Remidio Fundus on Phone · 1659 by 2212 pixels: 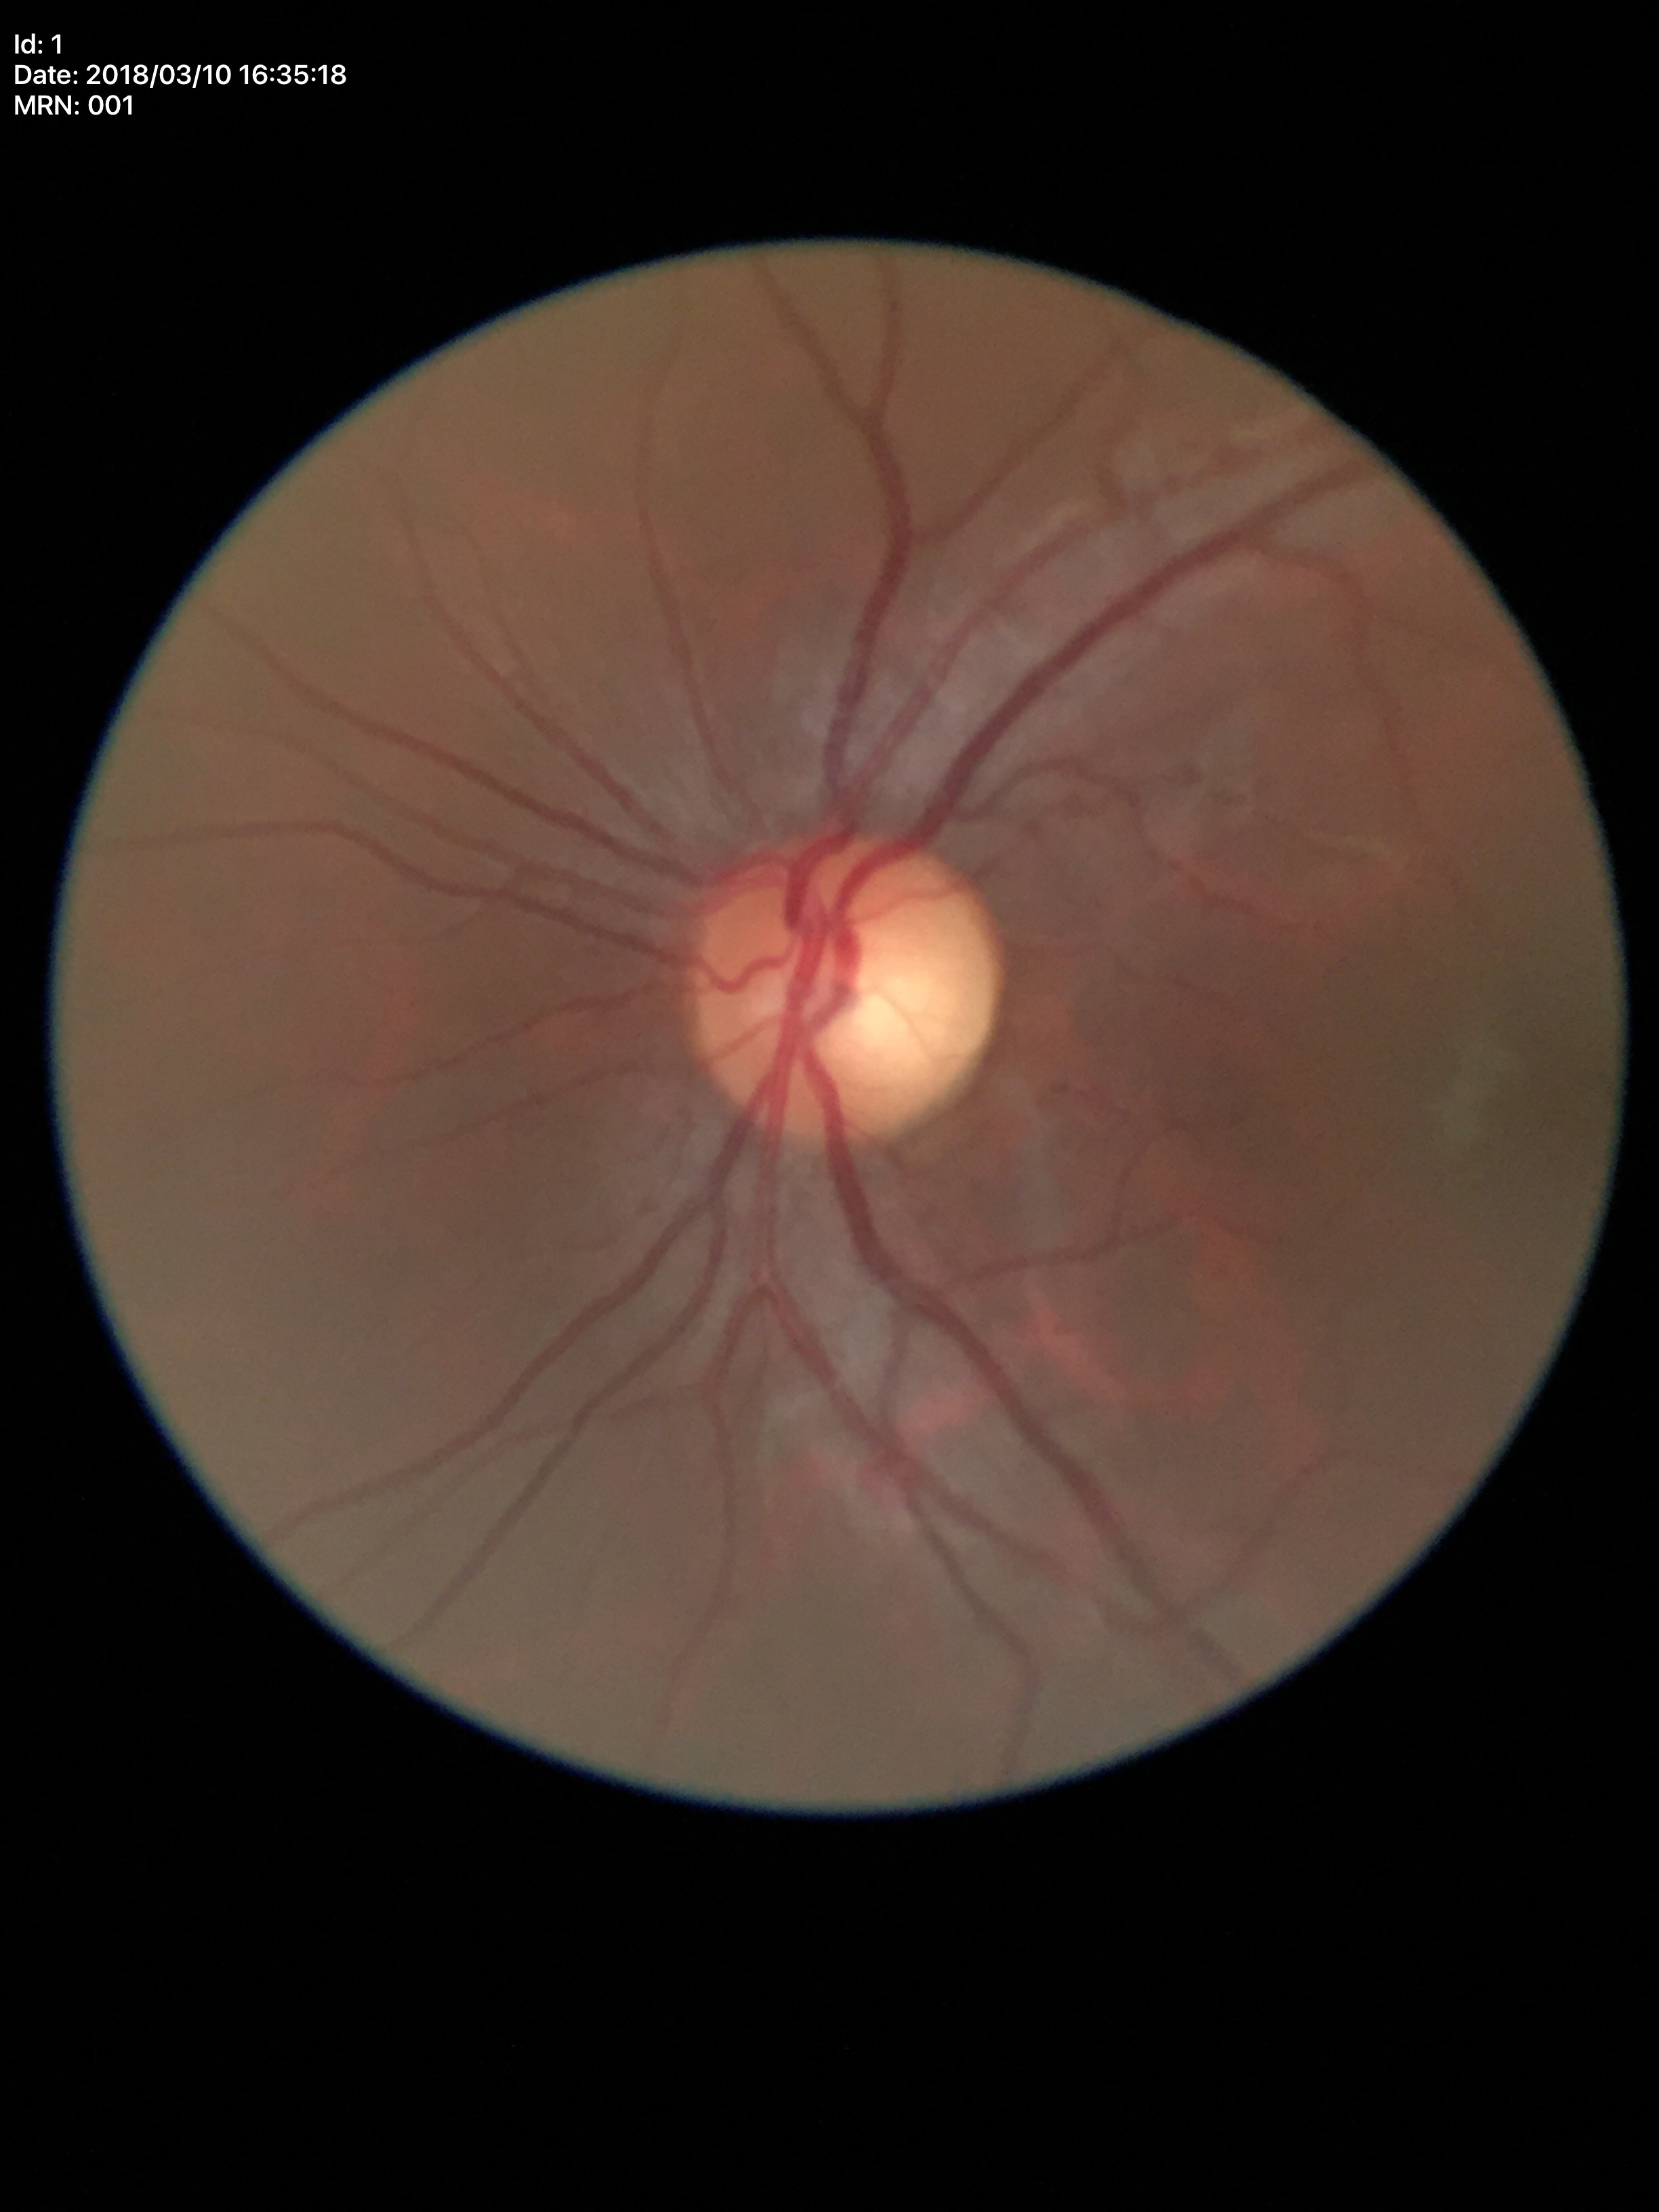

No glaucomatous optic neuropathy (5/5 ophthalmologists in agreement). HCDR: 0.55. VCDR of 0.53.